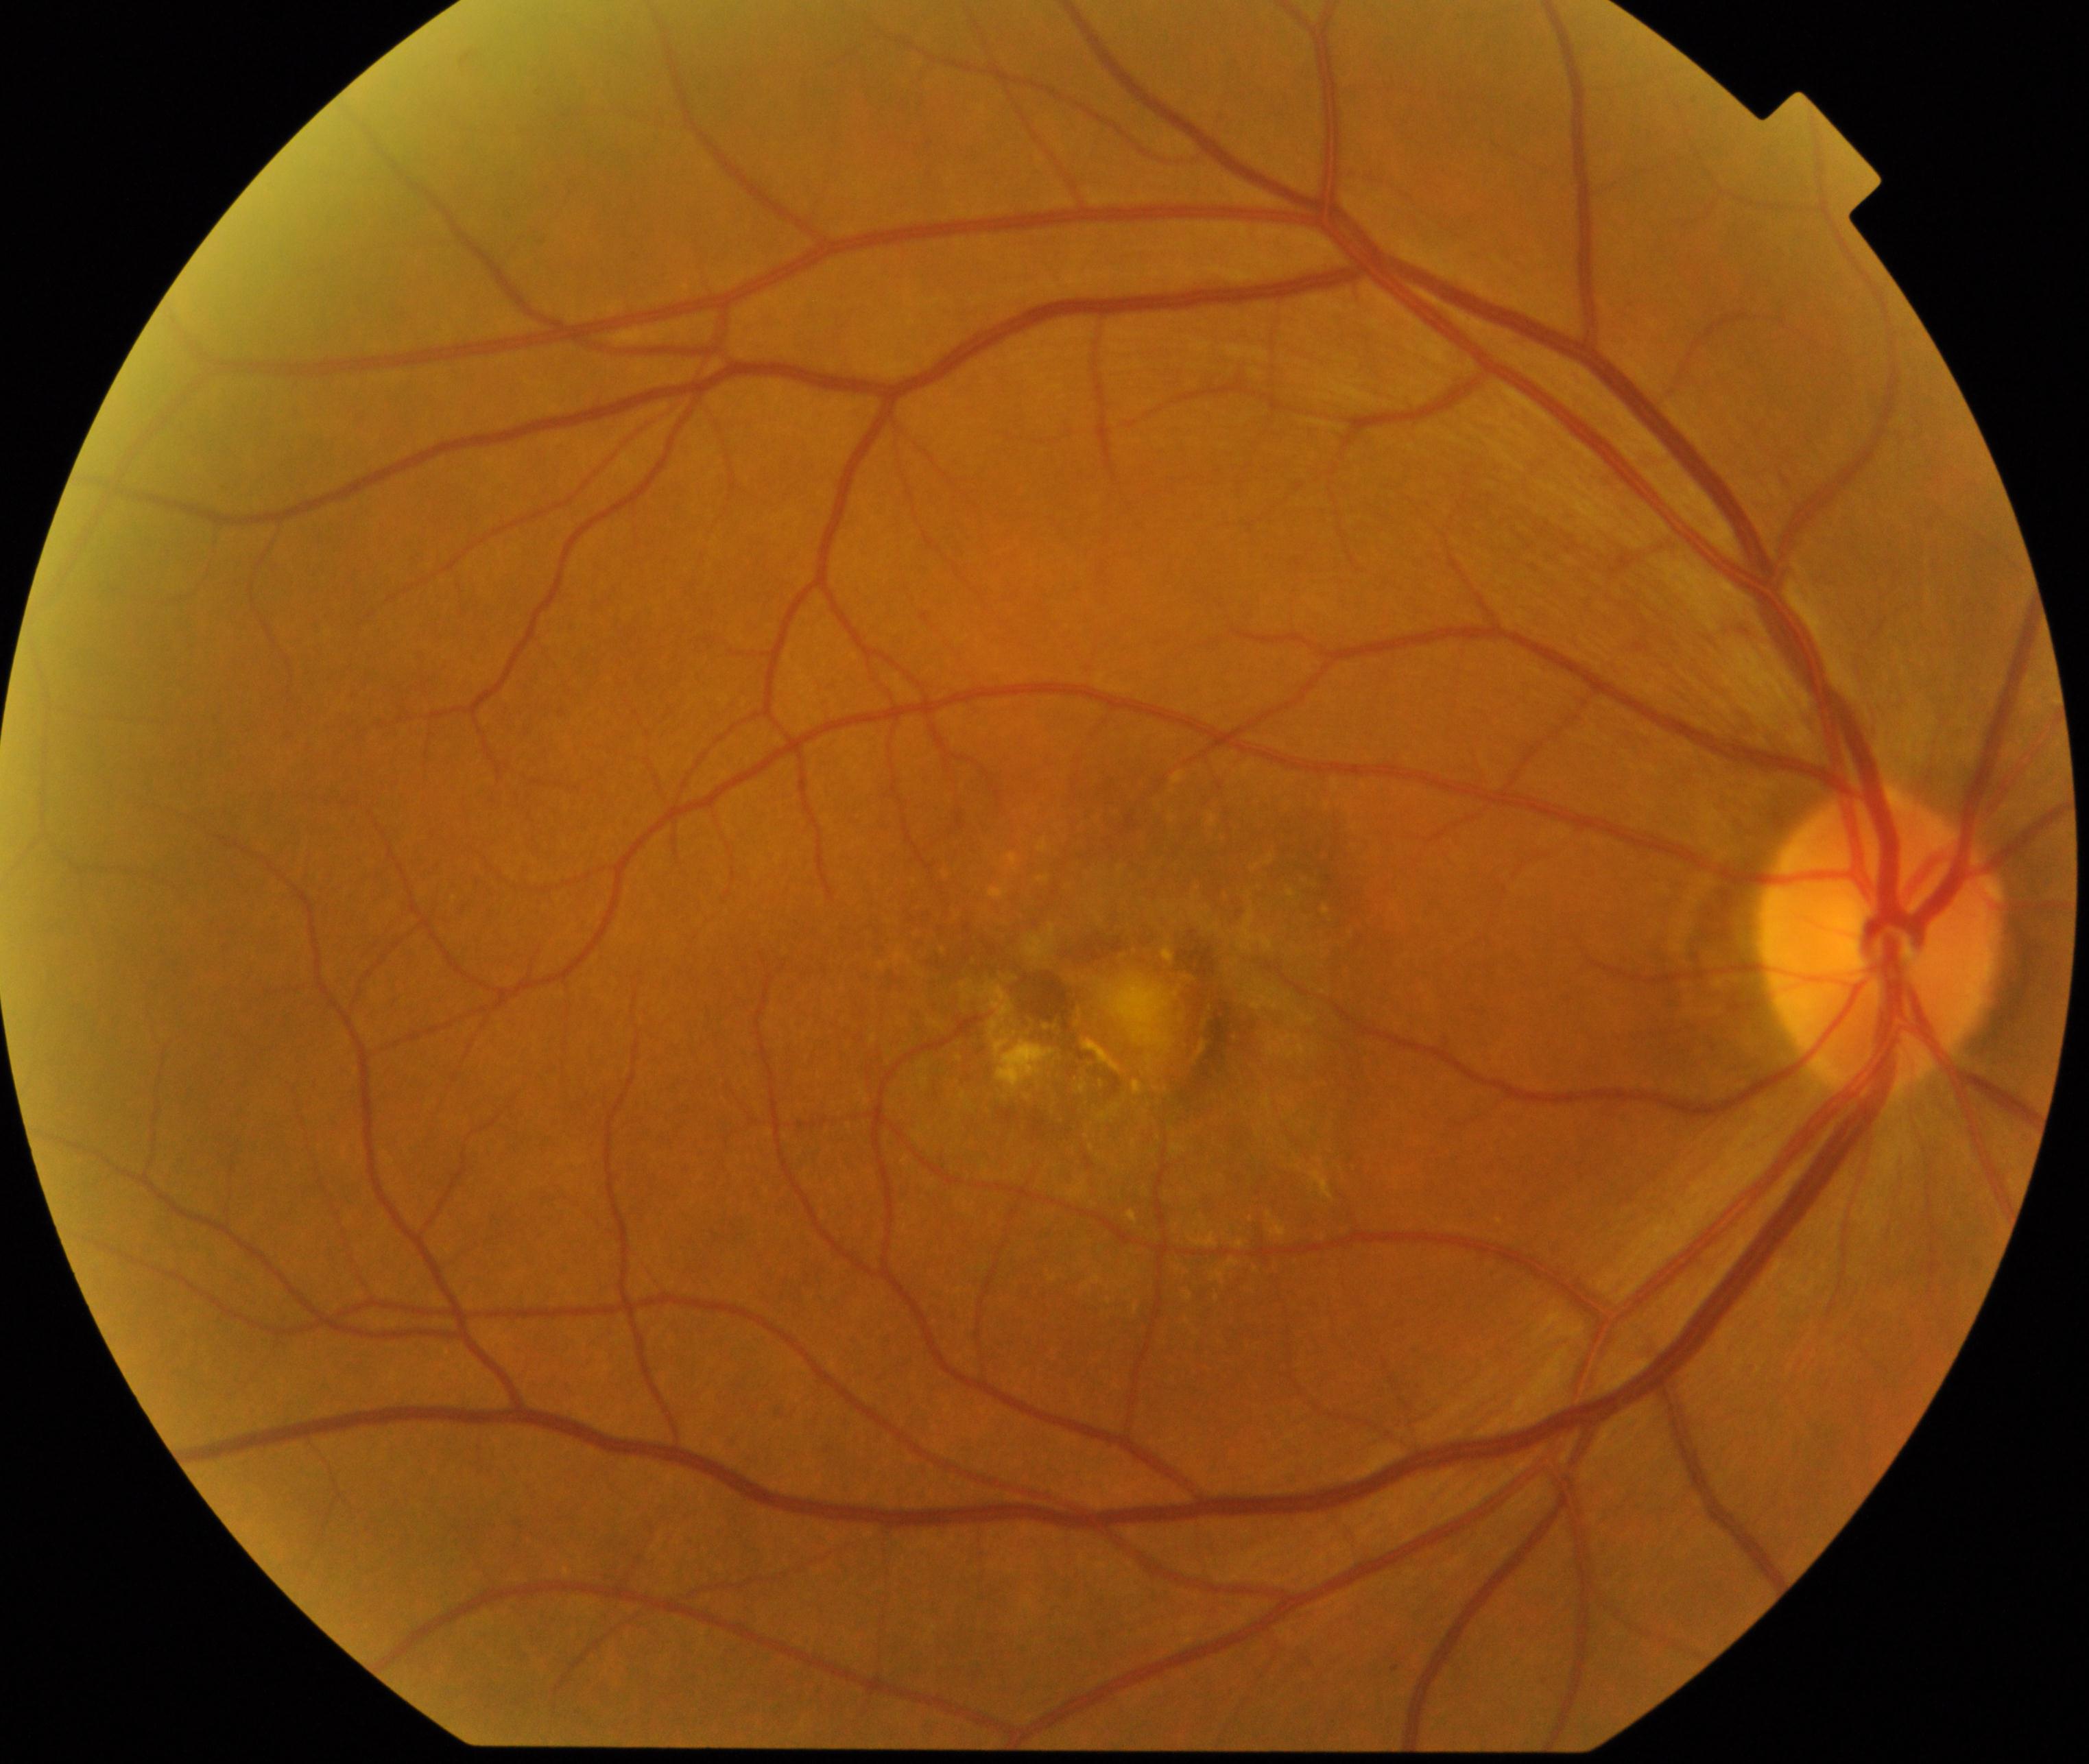
Fundus appearance consistent with maculopathy.